NIDEK AFC-230. 848x848. Color fundus photograph: 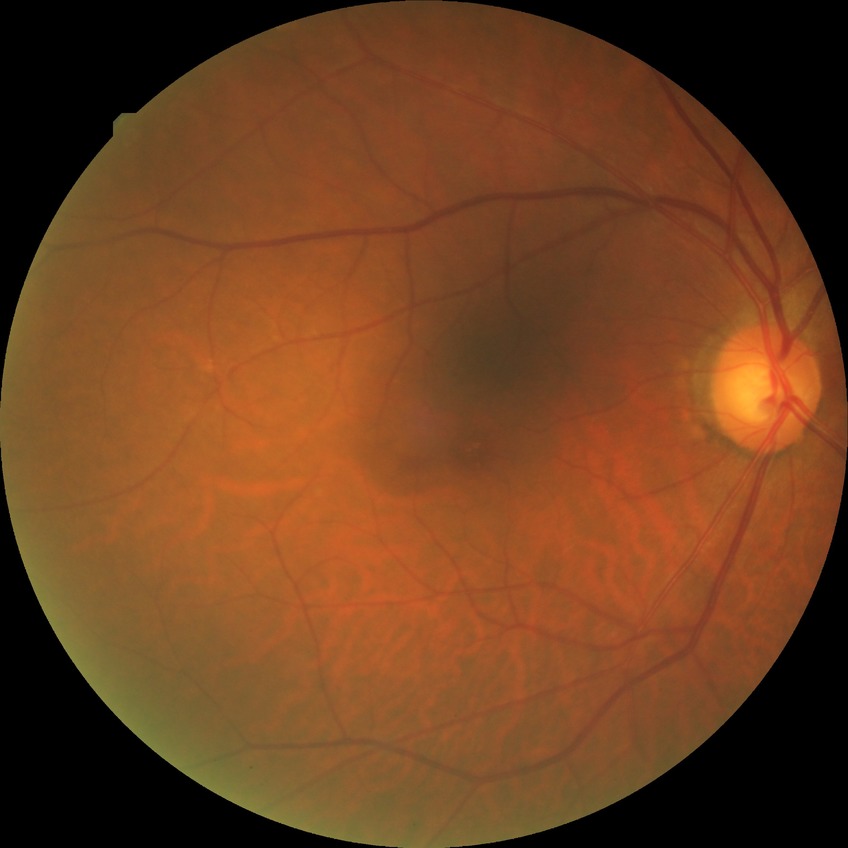 • diabetic retinopathy (DR) — NDR (no diabetic retinopathy)